45-degree field of view.
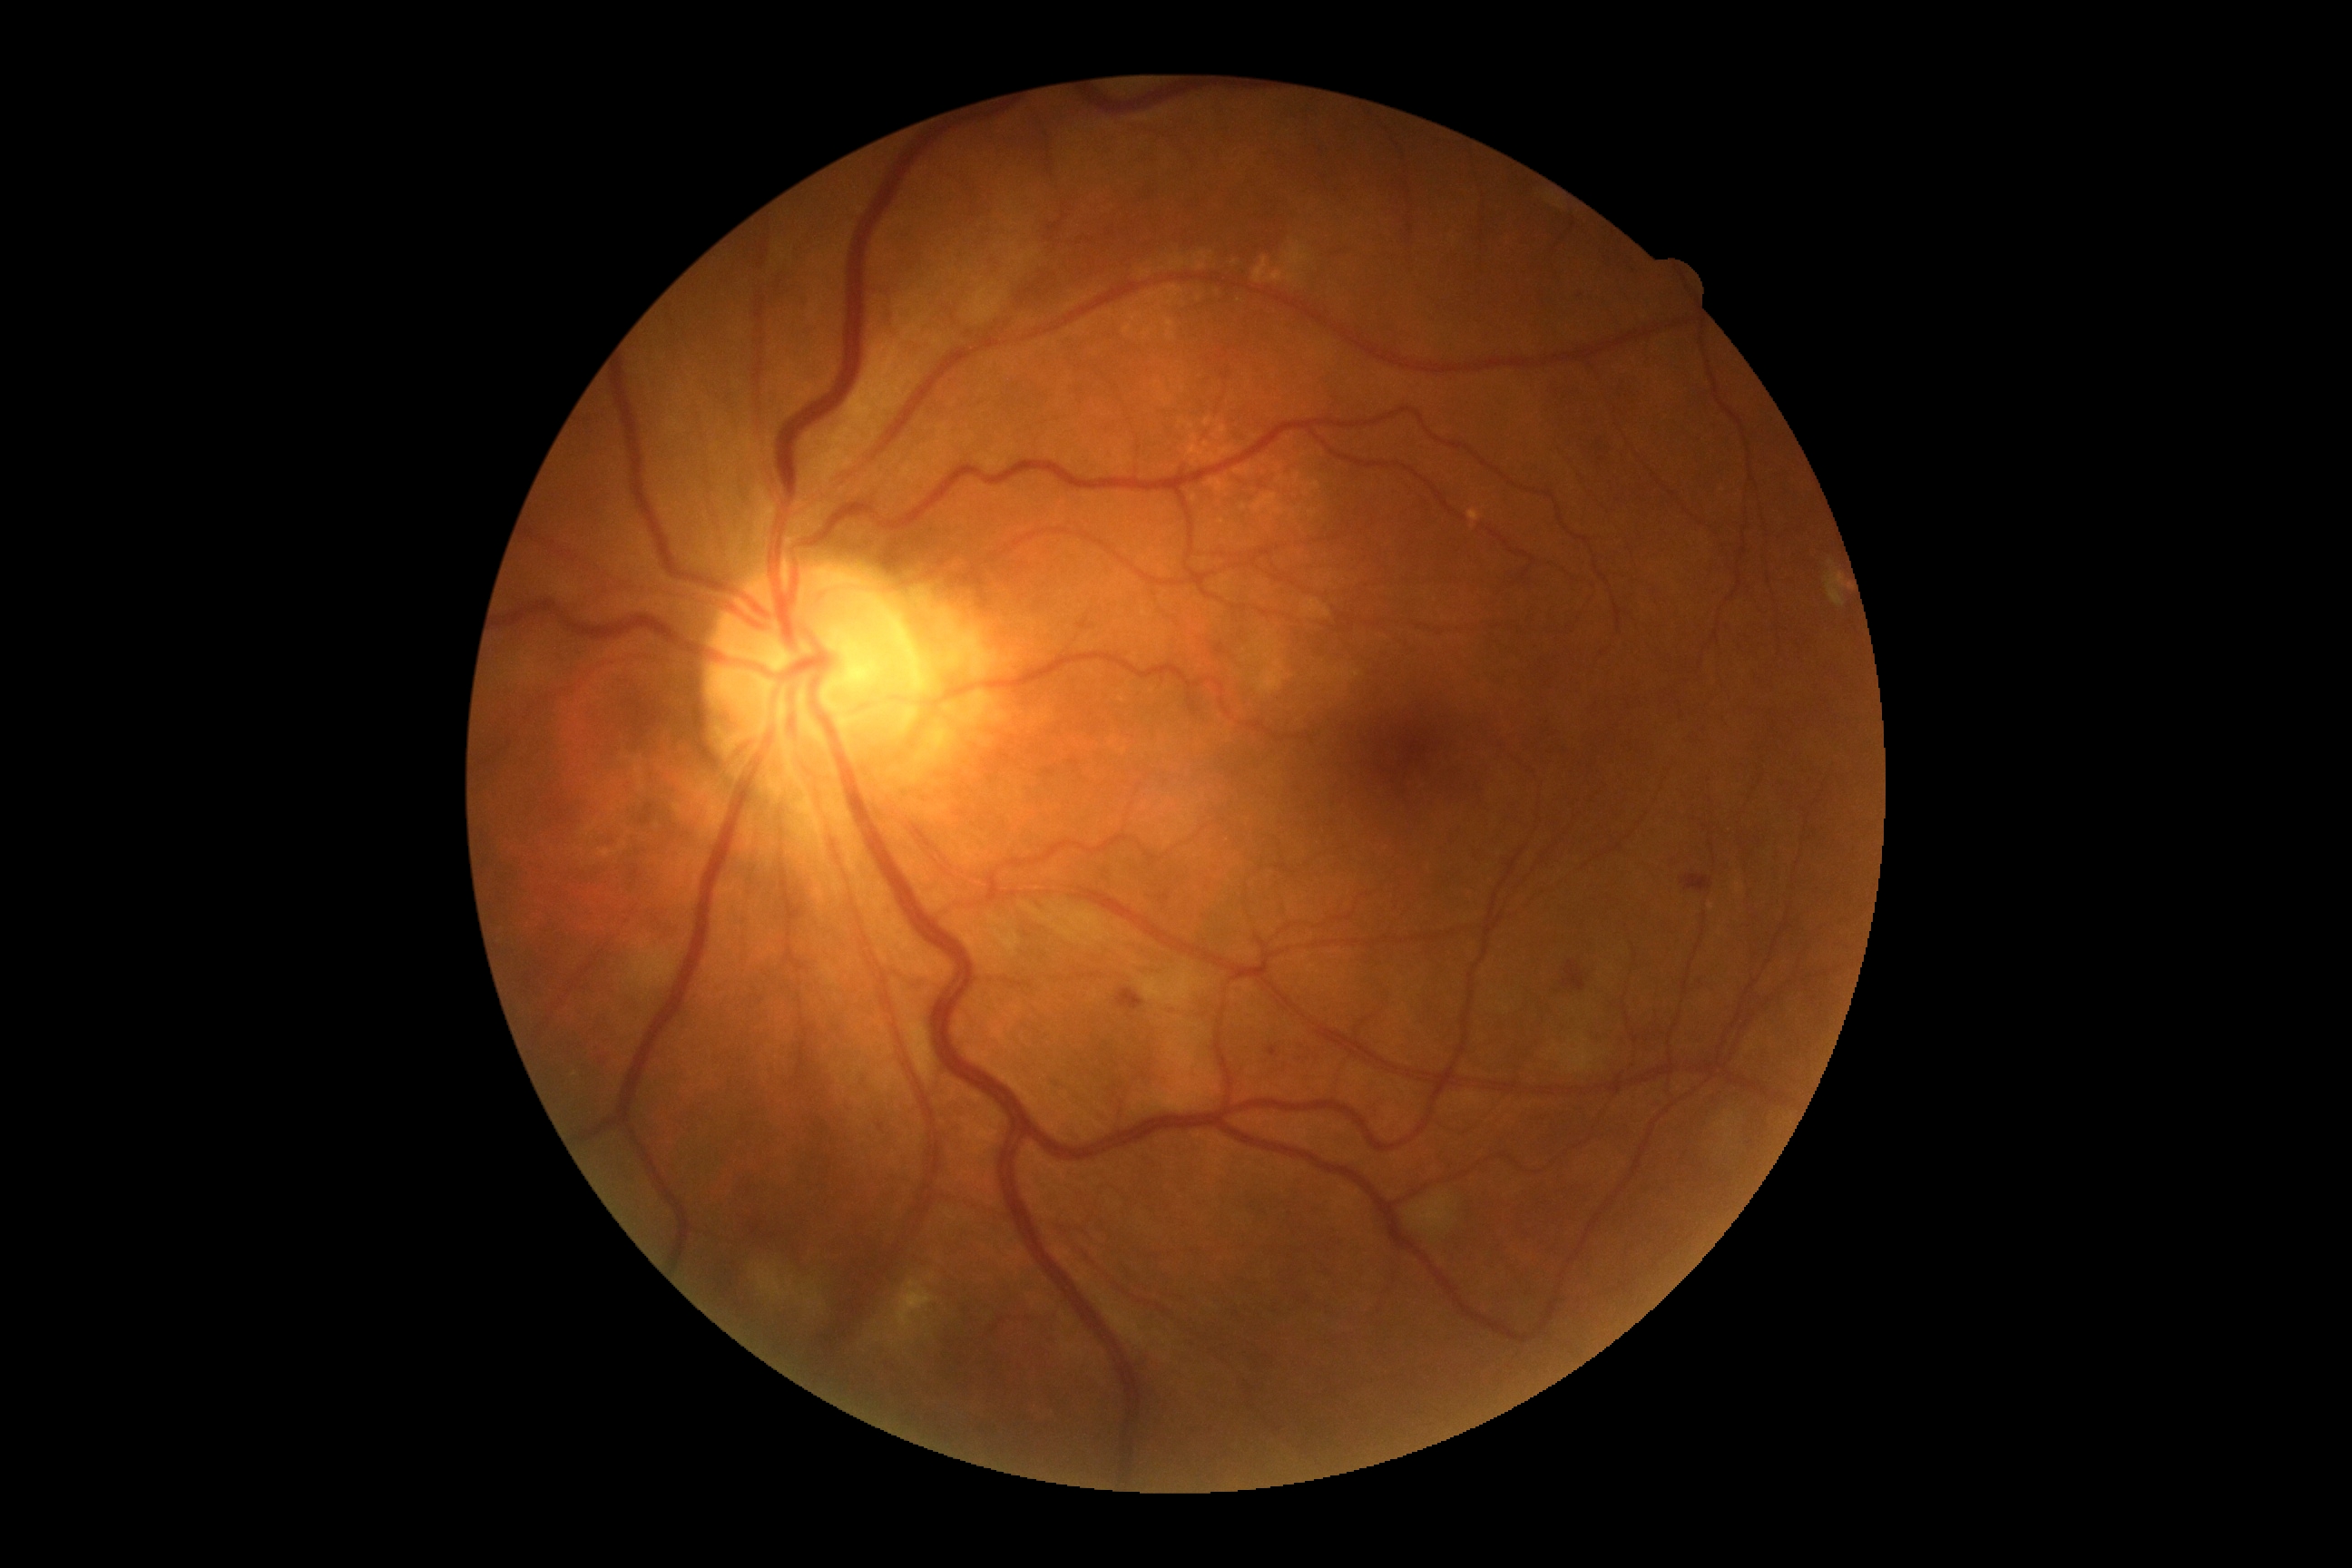

Diabetic retinopathy grade: 2/4 — more than just microaneurysms but less than severe NPDR.